2352 x 1568 pixels, 45° FOV: 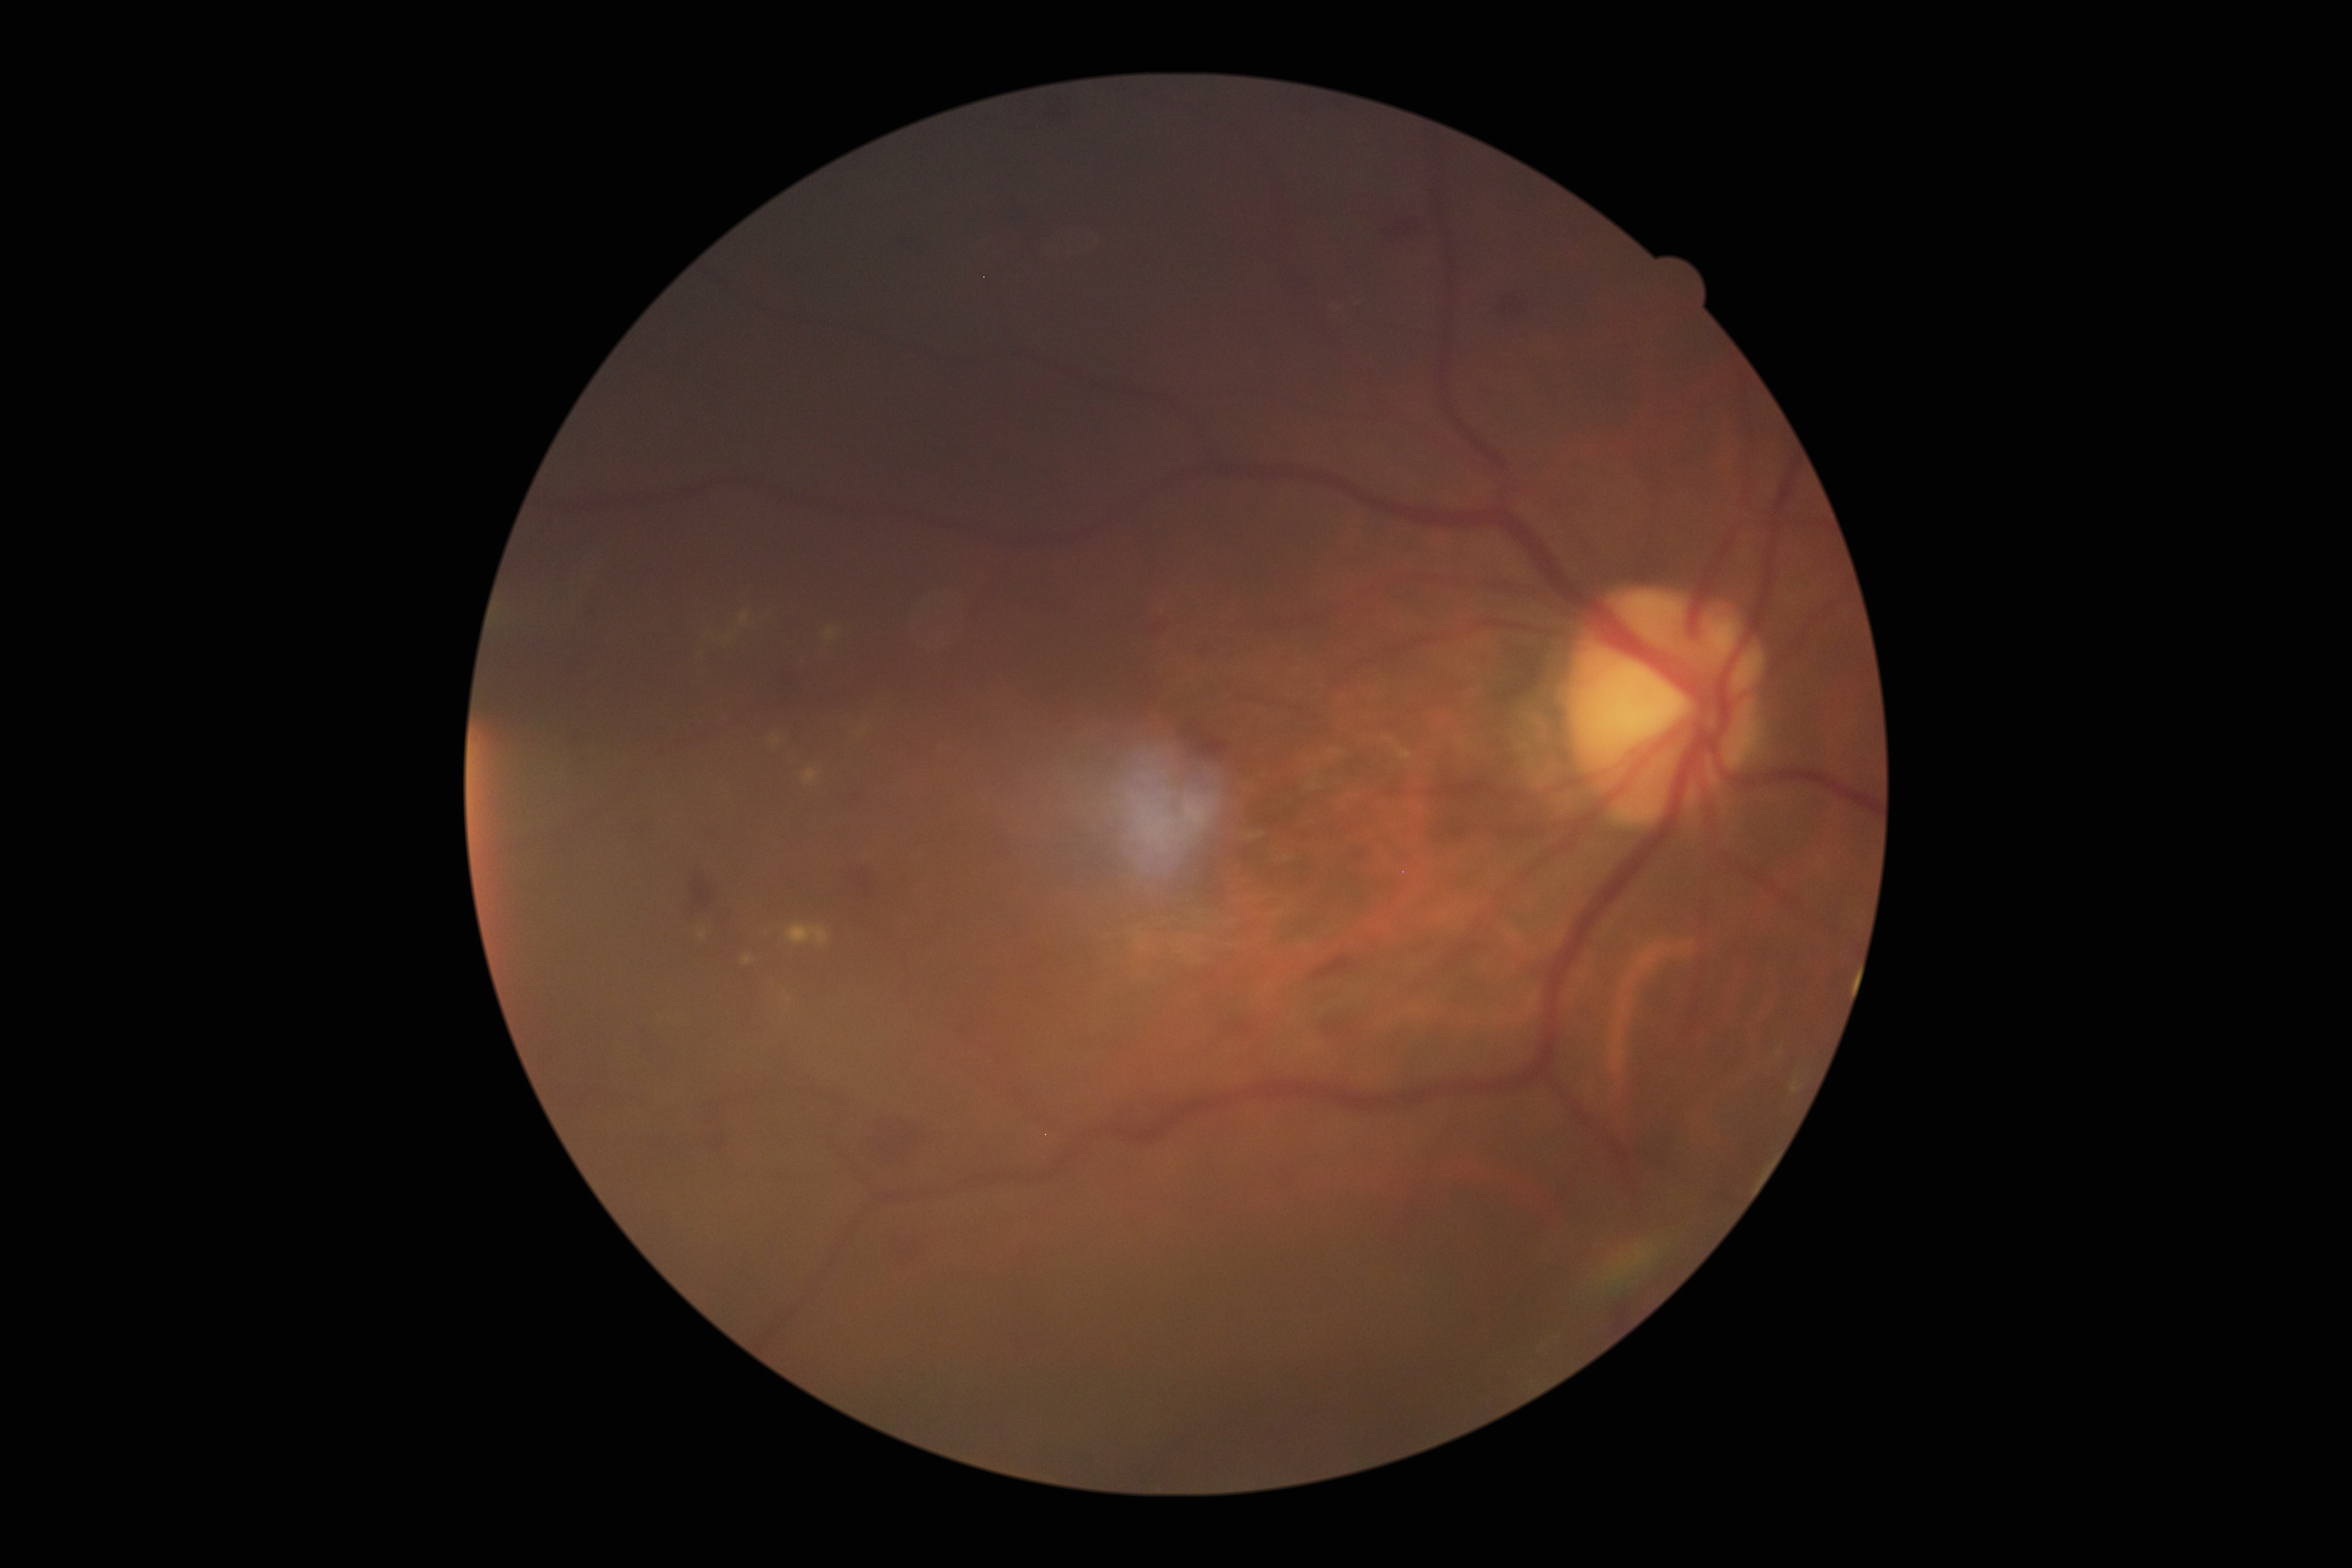 Diabetic retinopathy (DR): grade 2 (moderate NPDR).